Graded on the modified Davis scale.
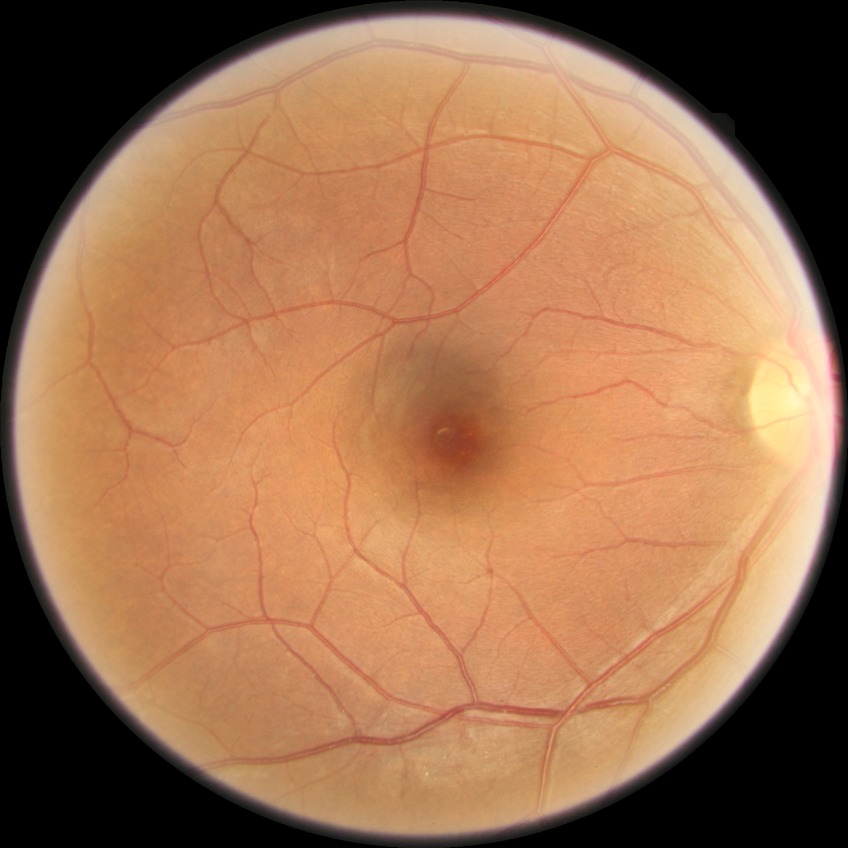
Diabetic retinopathy (DR): NDR (no diabetic retinopathy).